2048x1536.
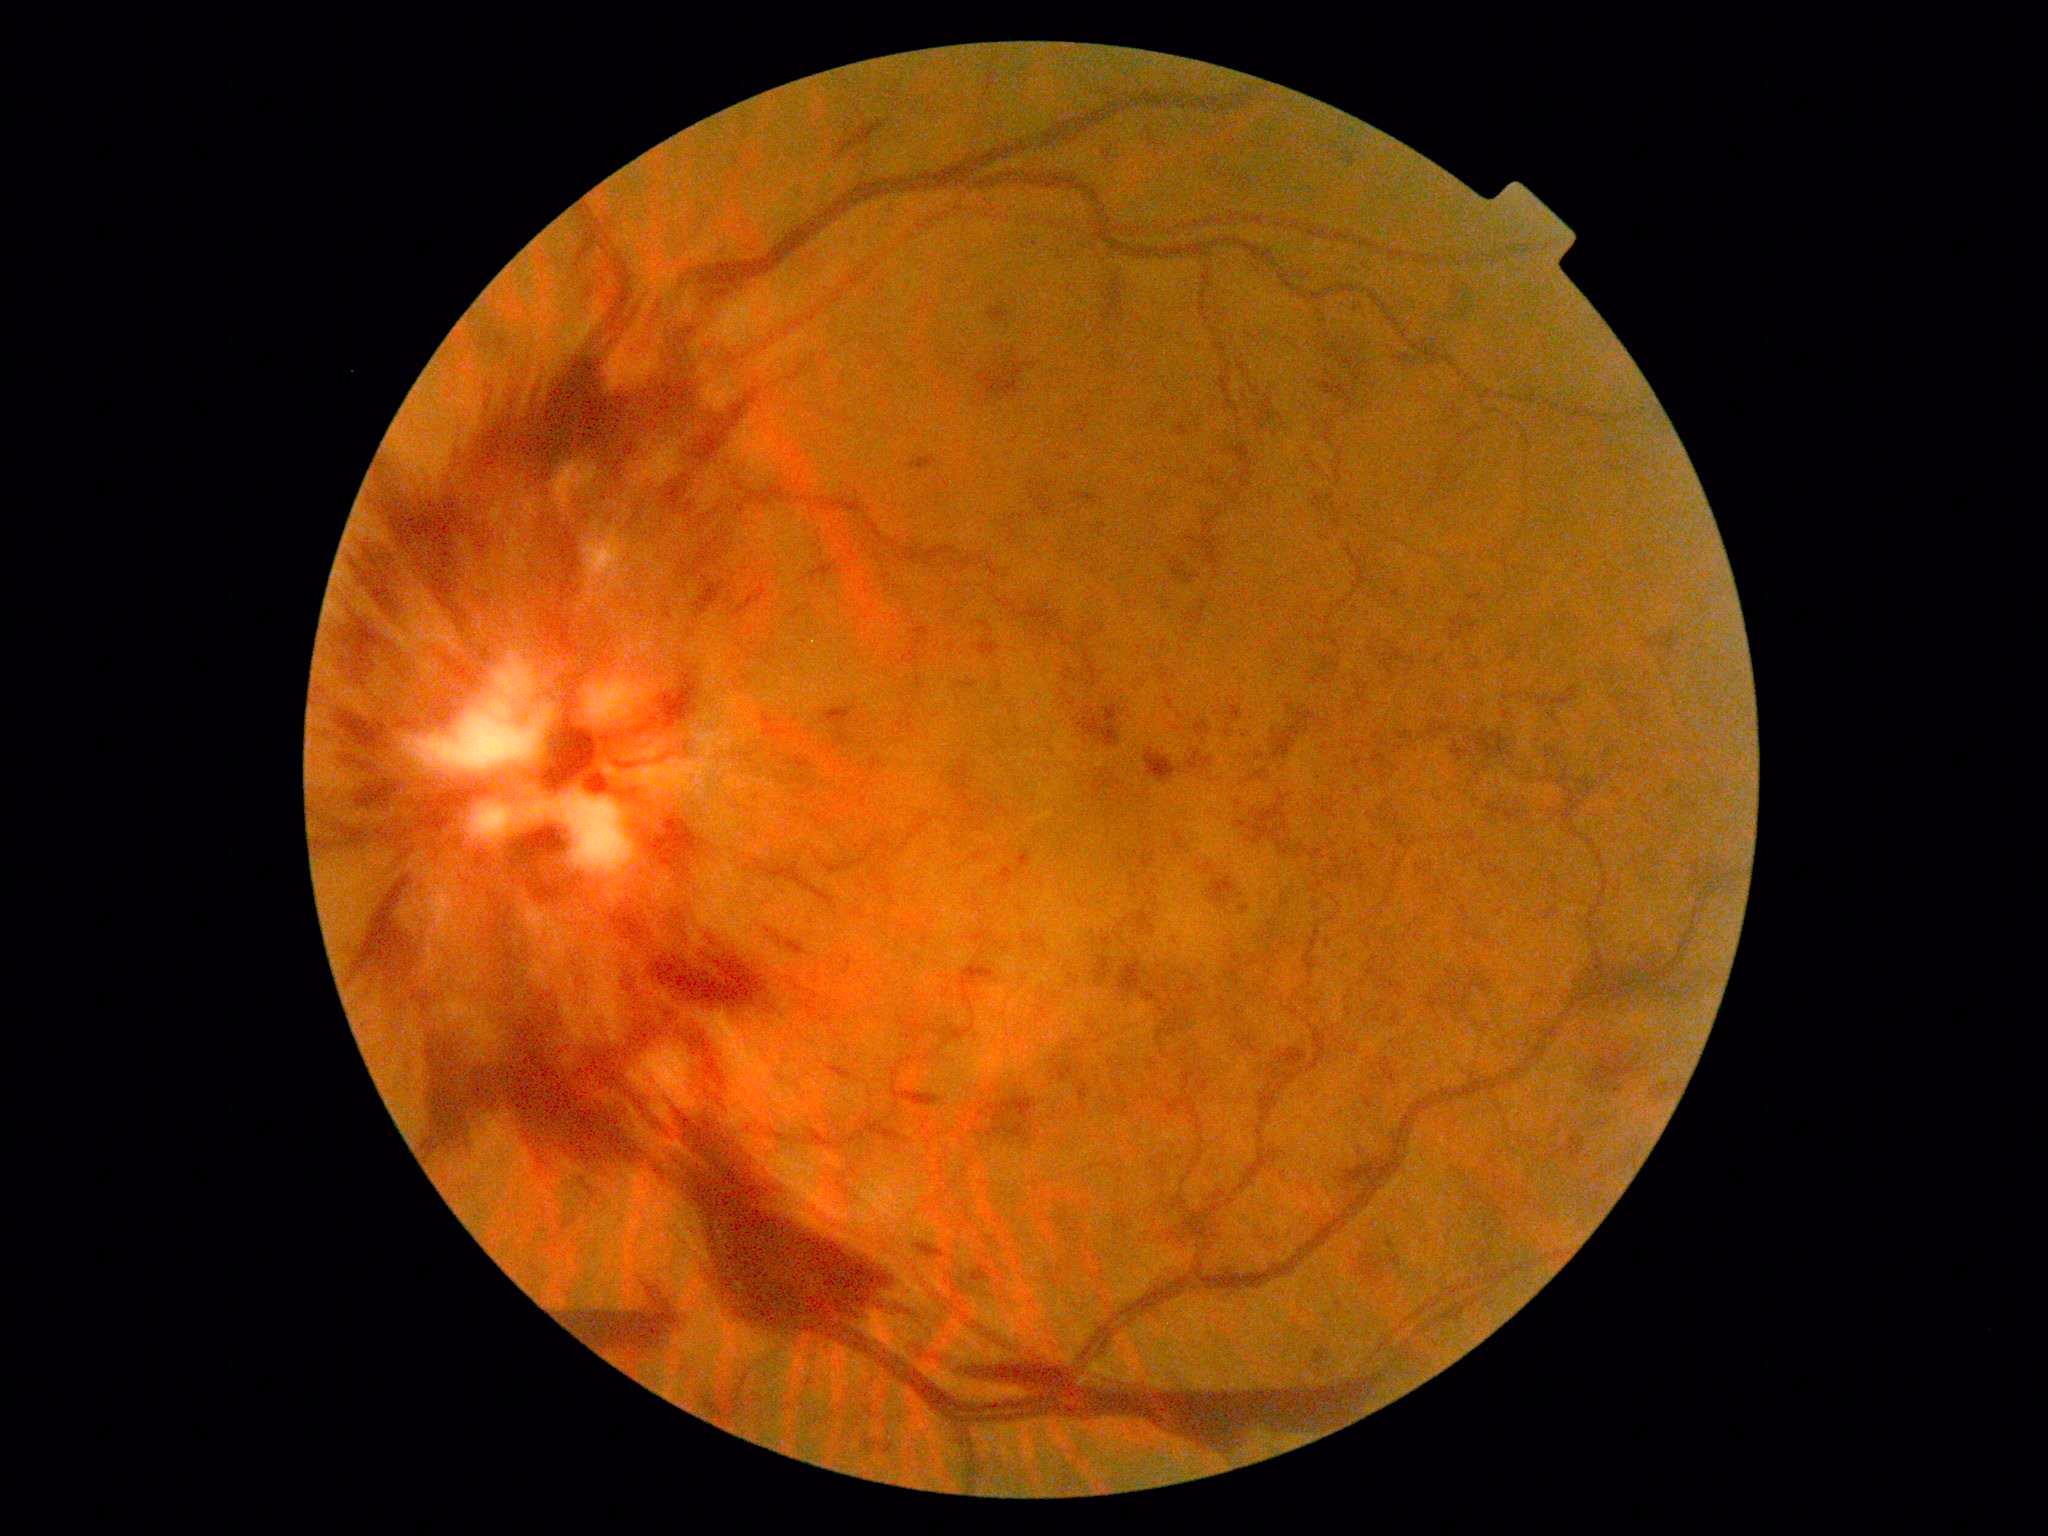

  dr_grade: PDR (grade 4)